Image size 2048x1536.
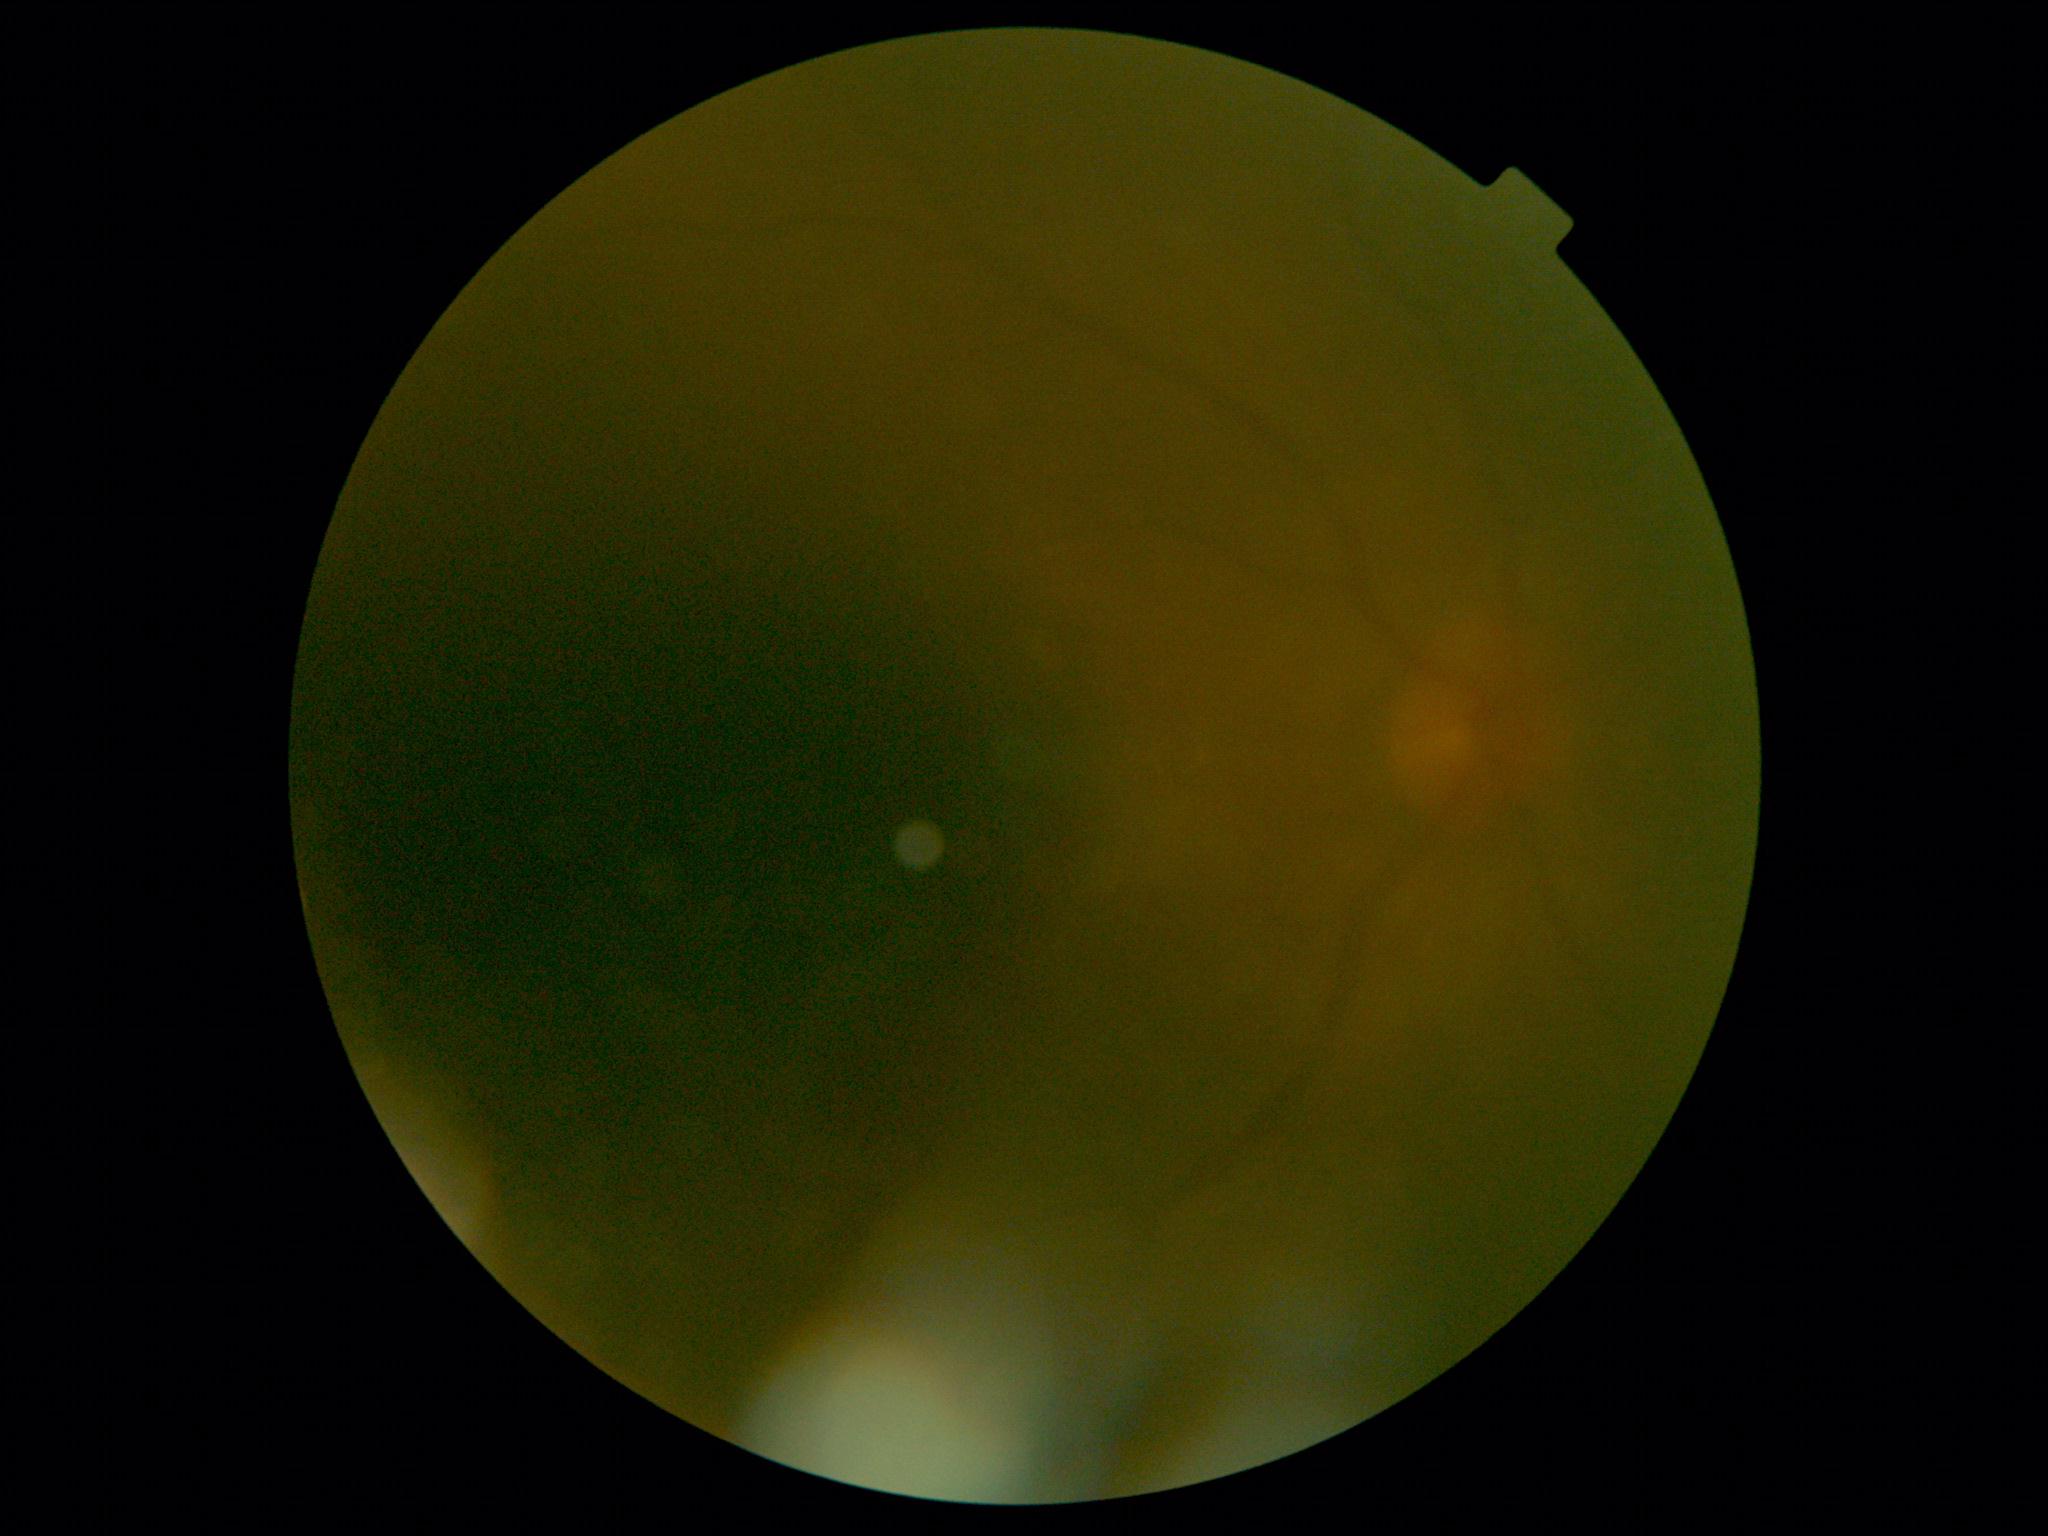
image quality: below grading threshold; DR: ungradable due to poor image quality.